45-degree field of view.
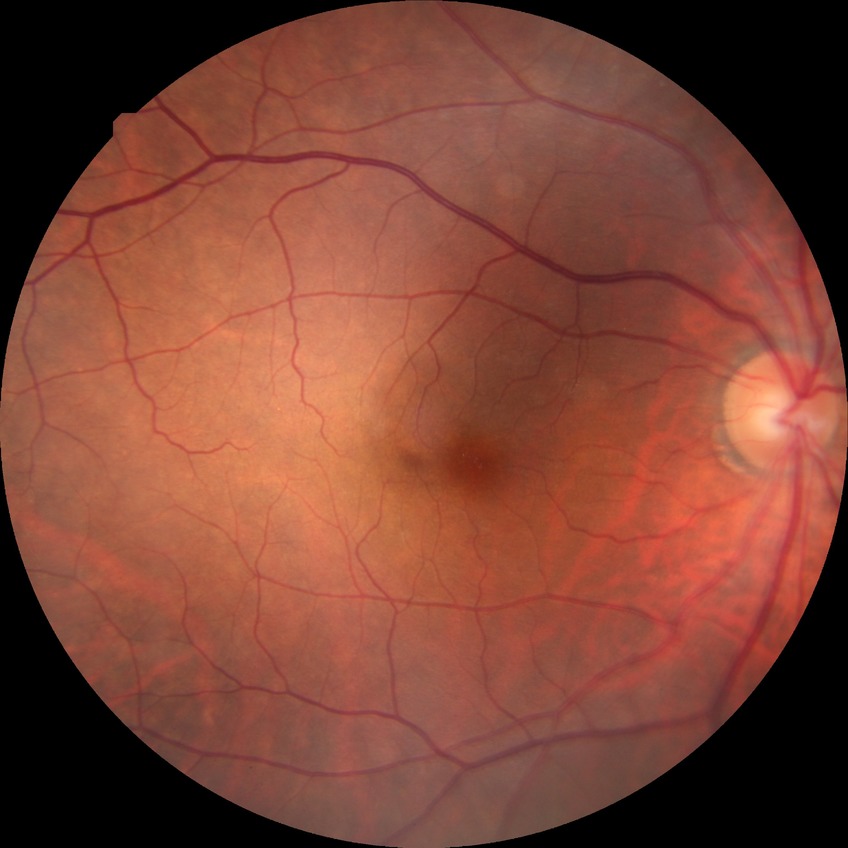
Diabetic retinopathy (DR): SDR (simple diabetic retinopathy).